Cropped to the optic nerve head: 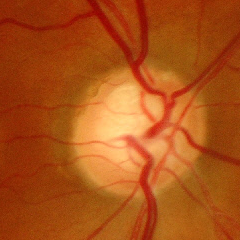 Glaucomatous optic neuropathy is present. Glaucoma status = severe glaucomatous damage.